45-degree field of view.
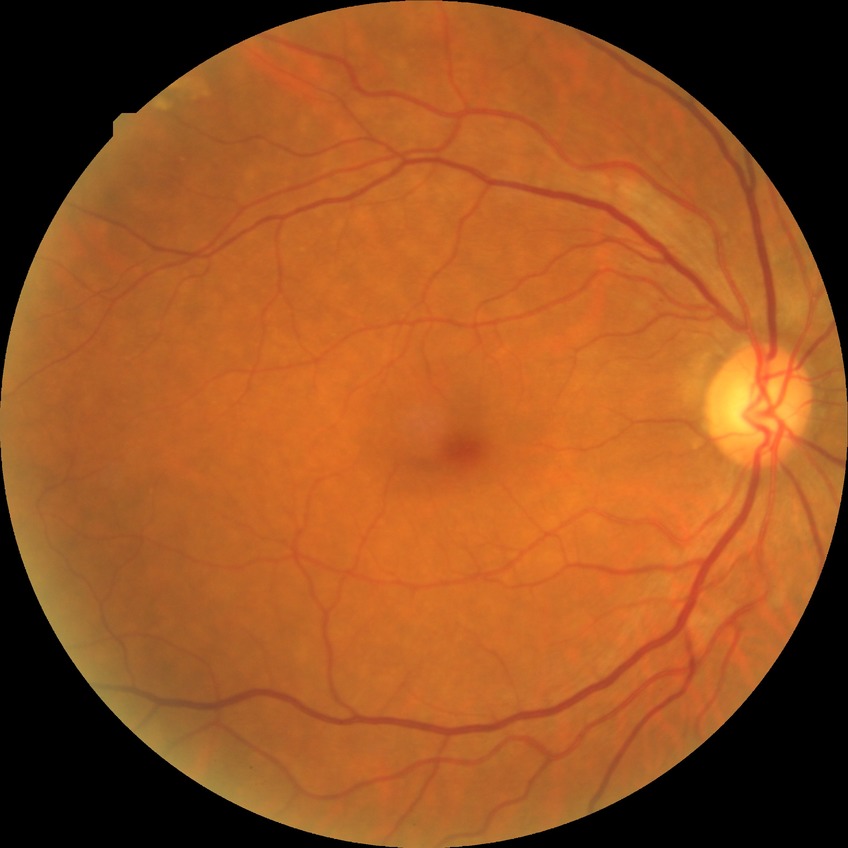

modified Davis classification: no diabetic retinopathy.